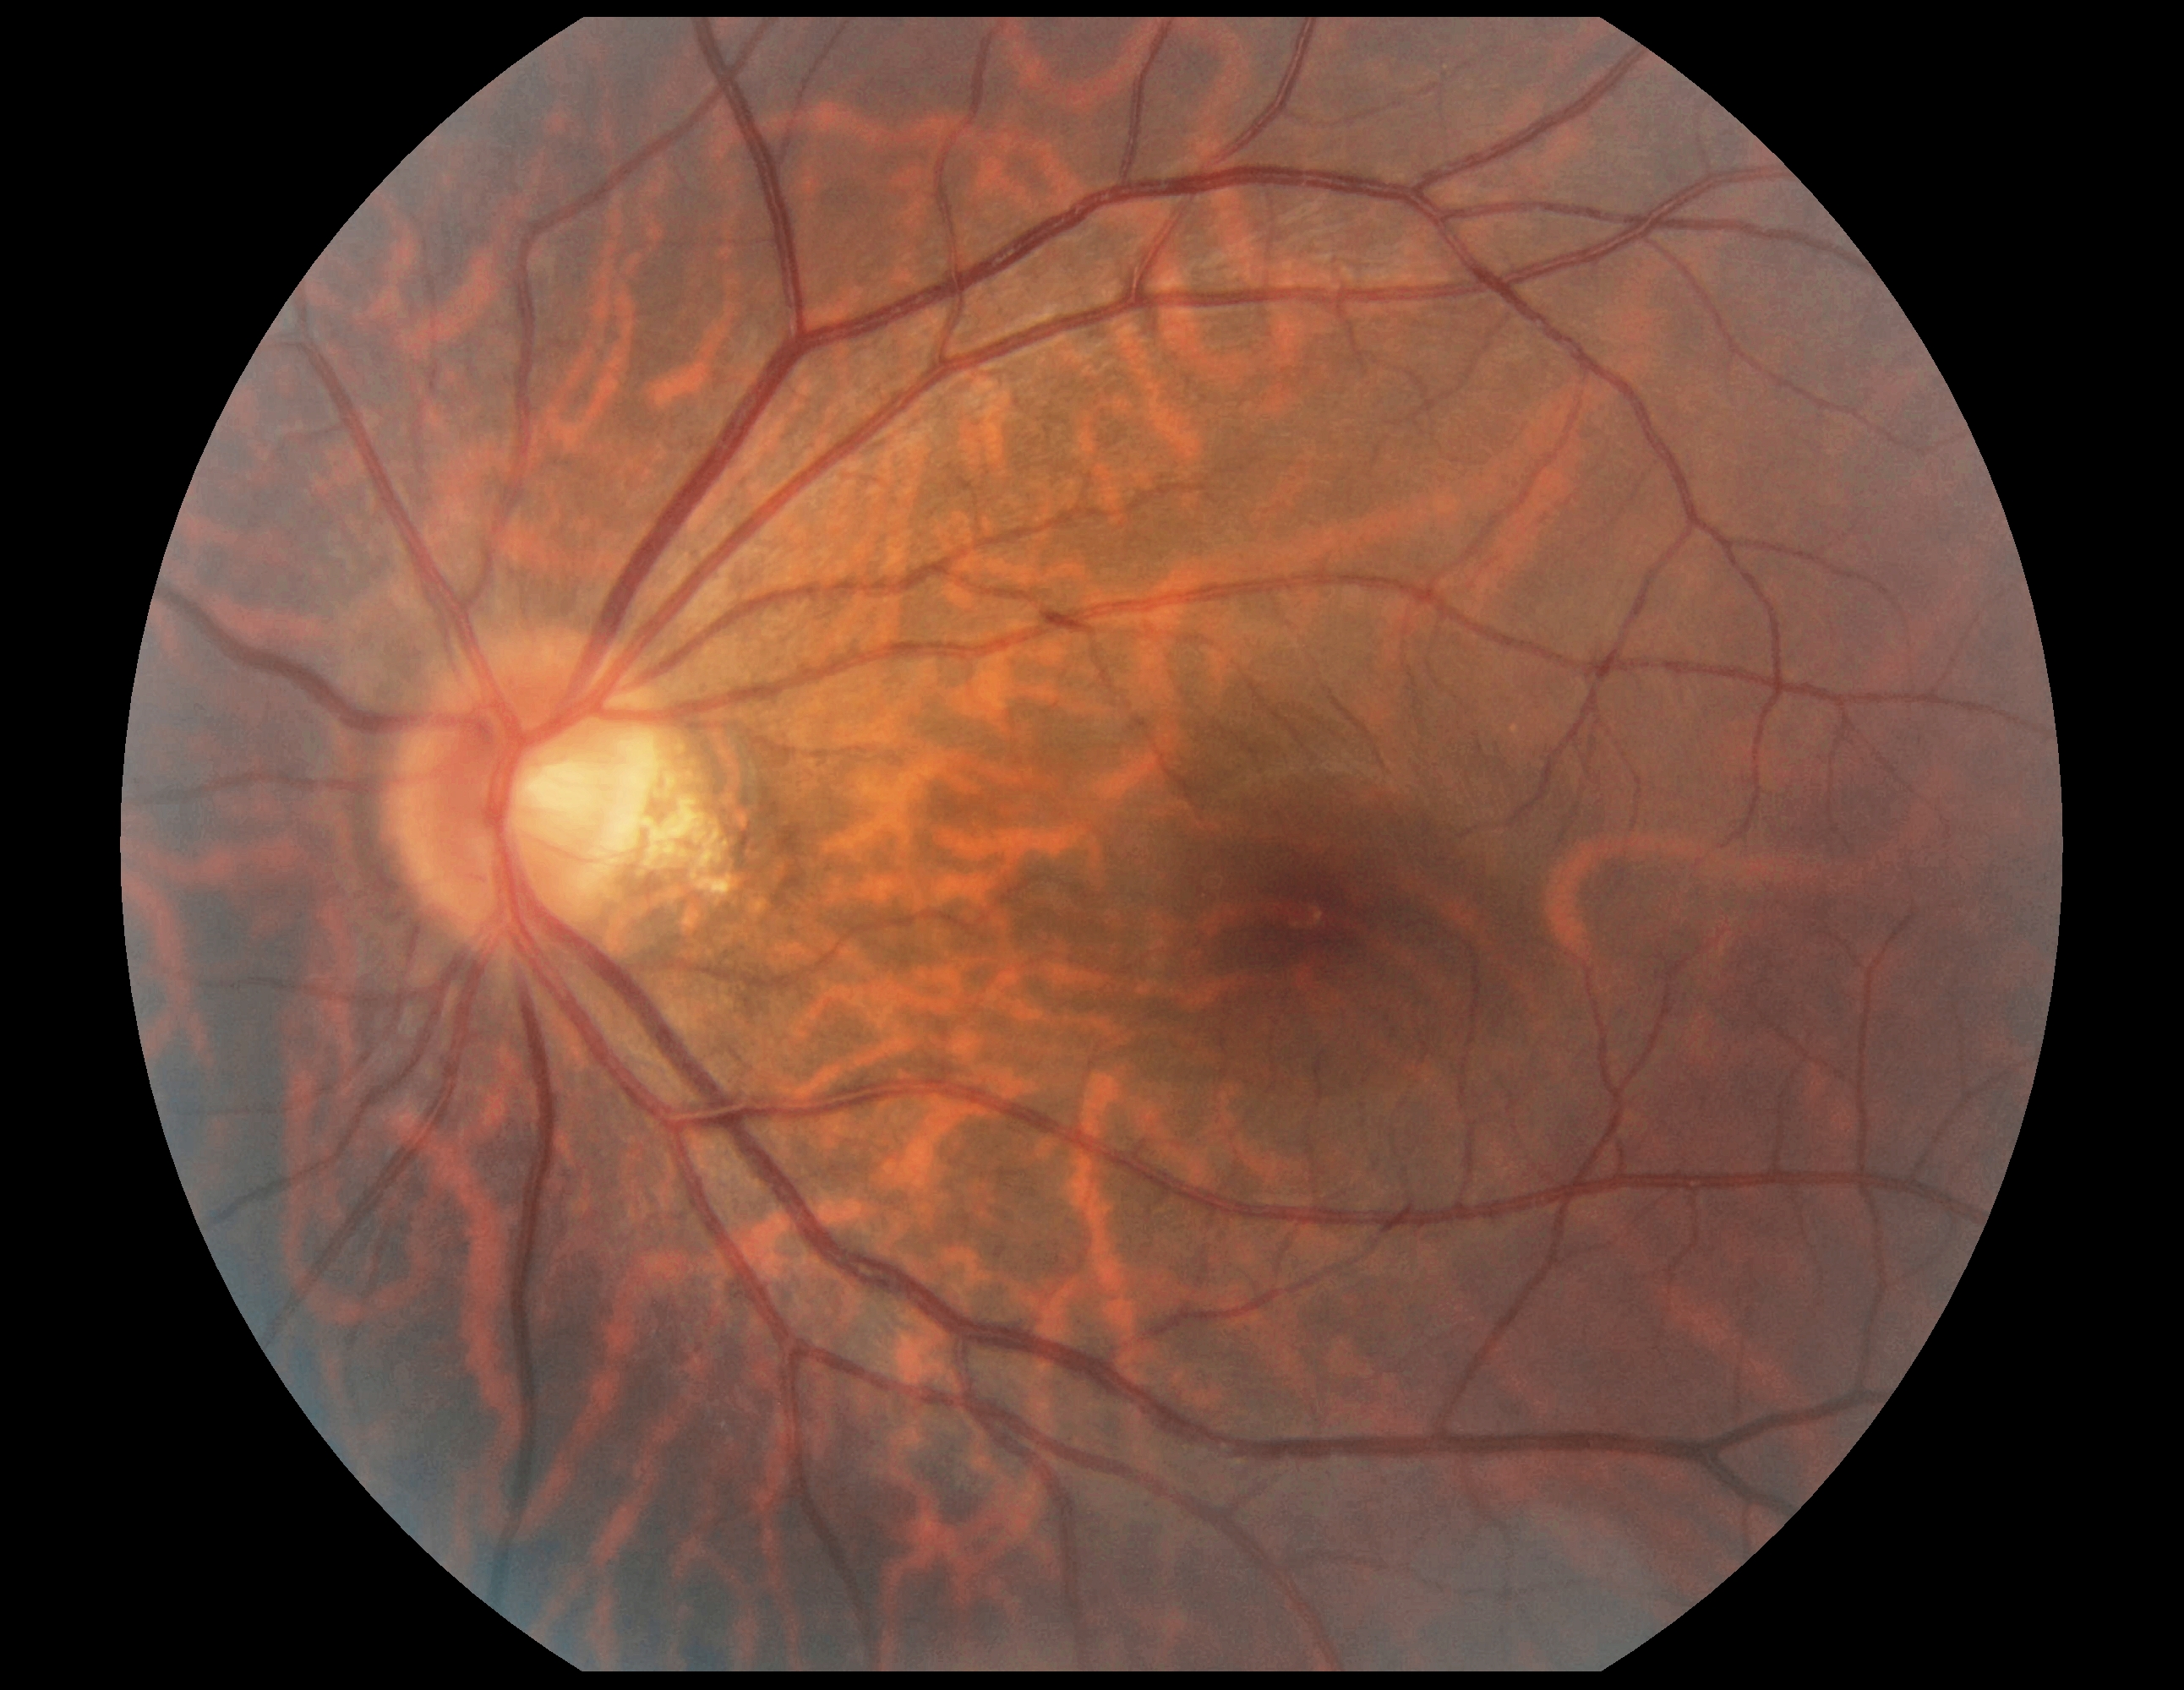 DR grade is 0 (no apparent retinopathy).